Image size 848x848, retinal fundus photograph, acquired with a NIDEK AFC-230:
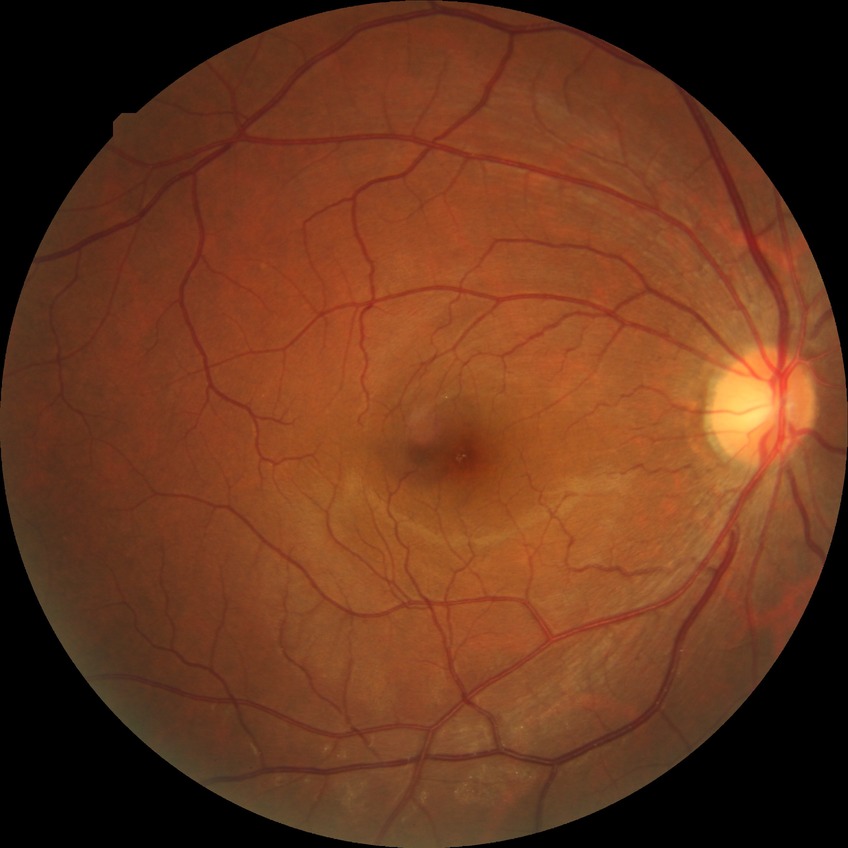 Diabetic retinopathy grade is no diabetic retinopathy.